Ultra-widefield fundus photograph · image size 1924x1556
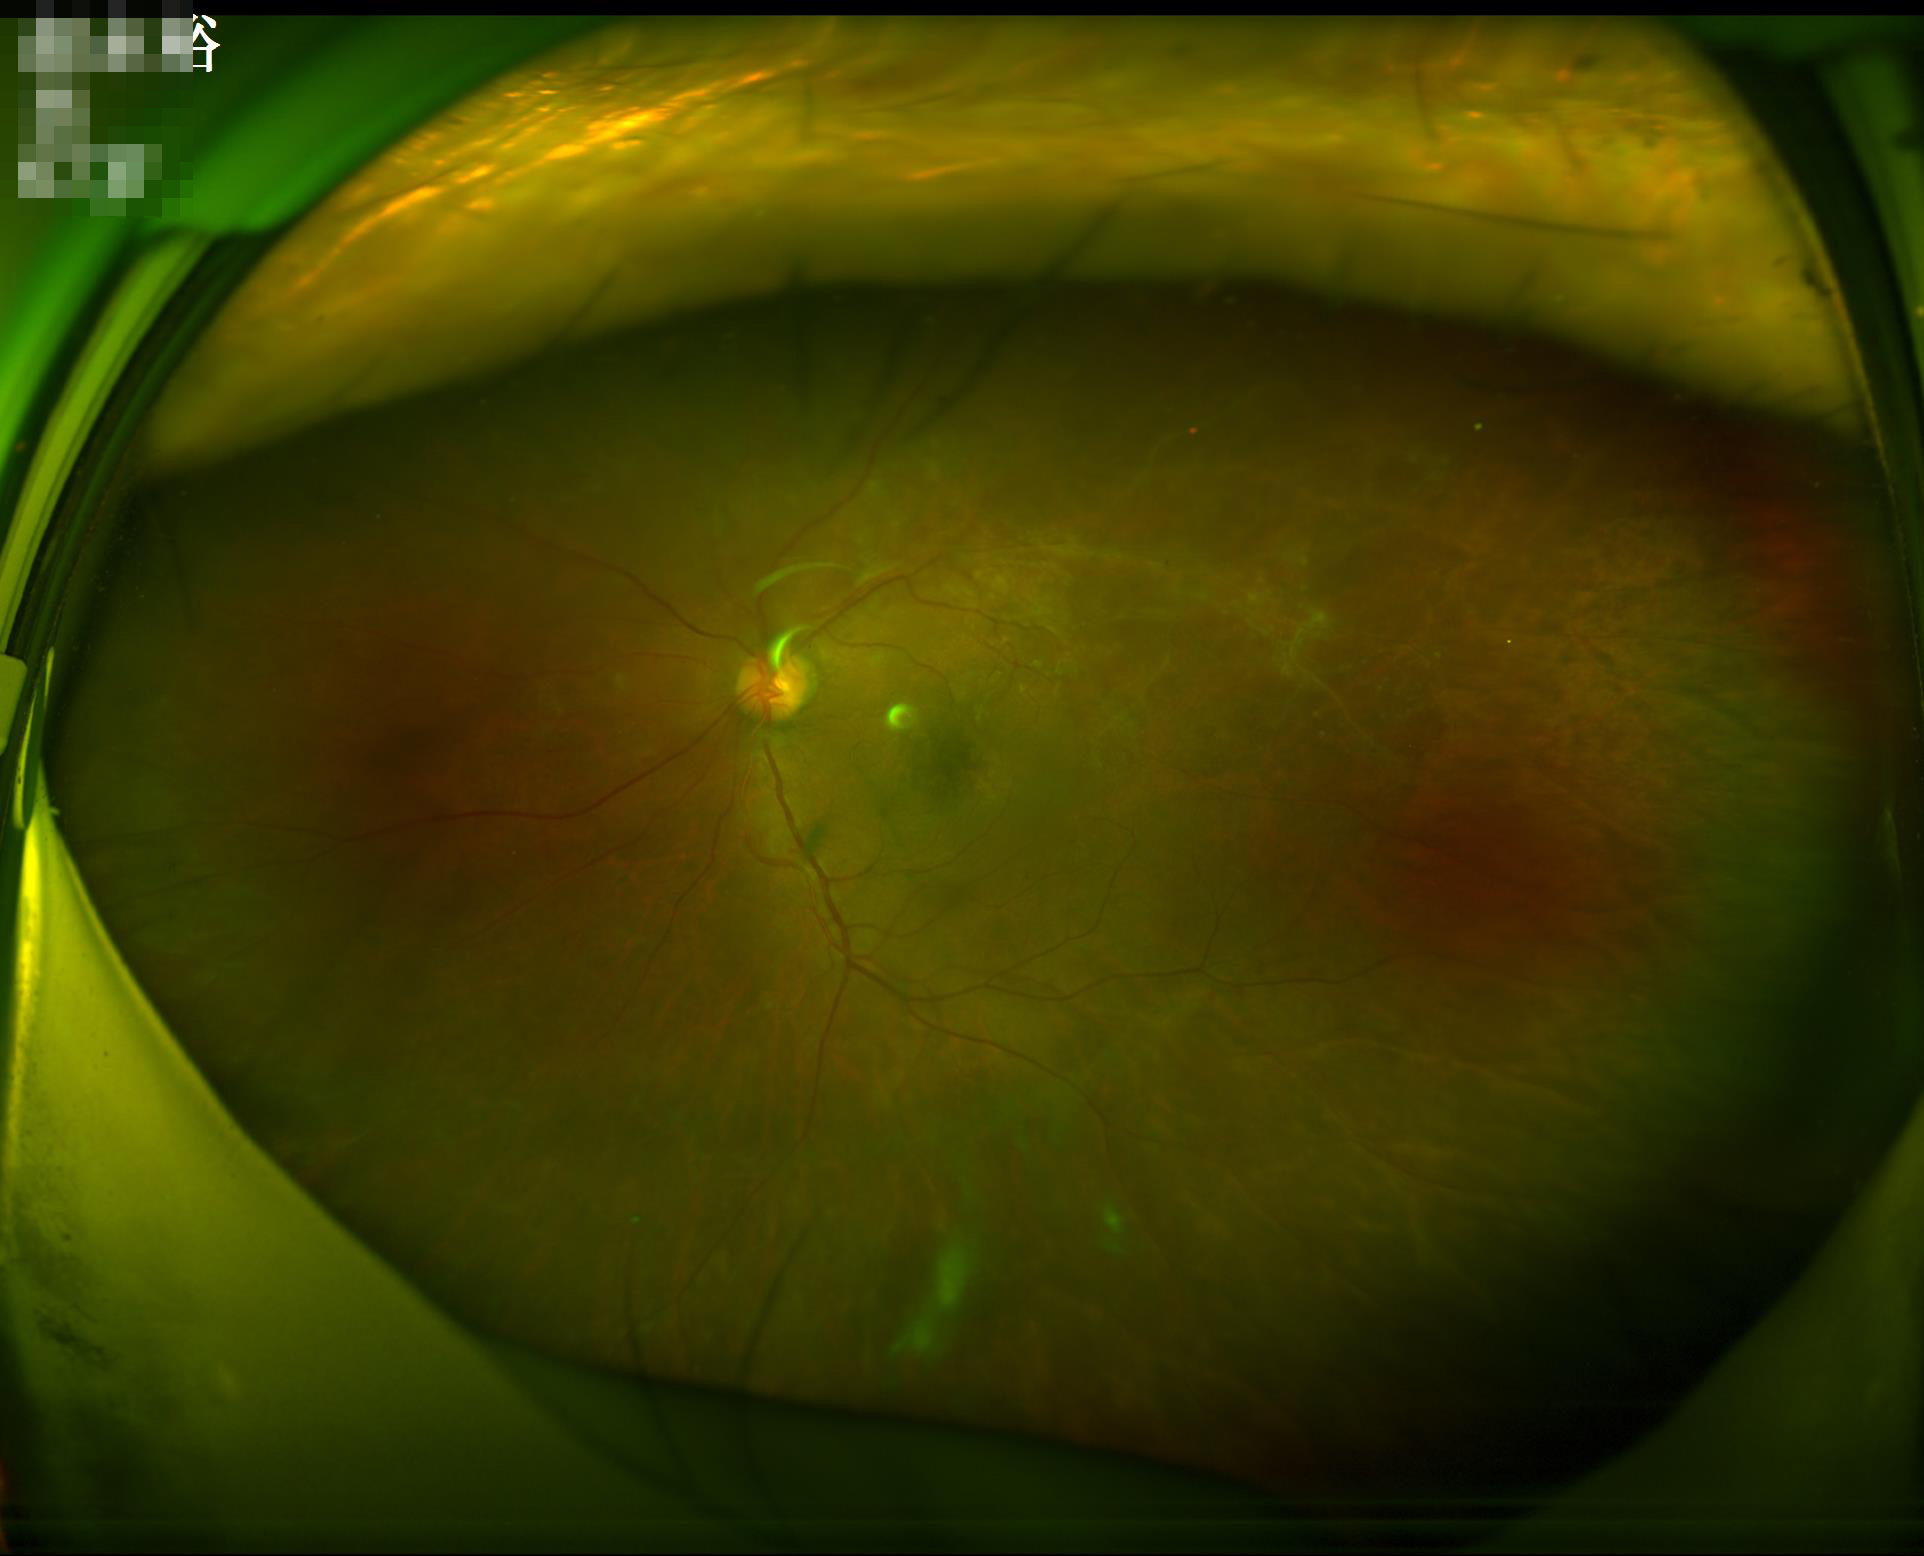
Sharpness = reduced sharpness with visible blur | Overall = good, gradable.